Infant wide-field retinal image.
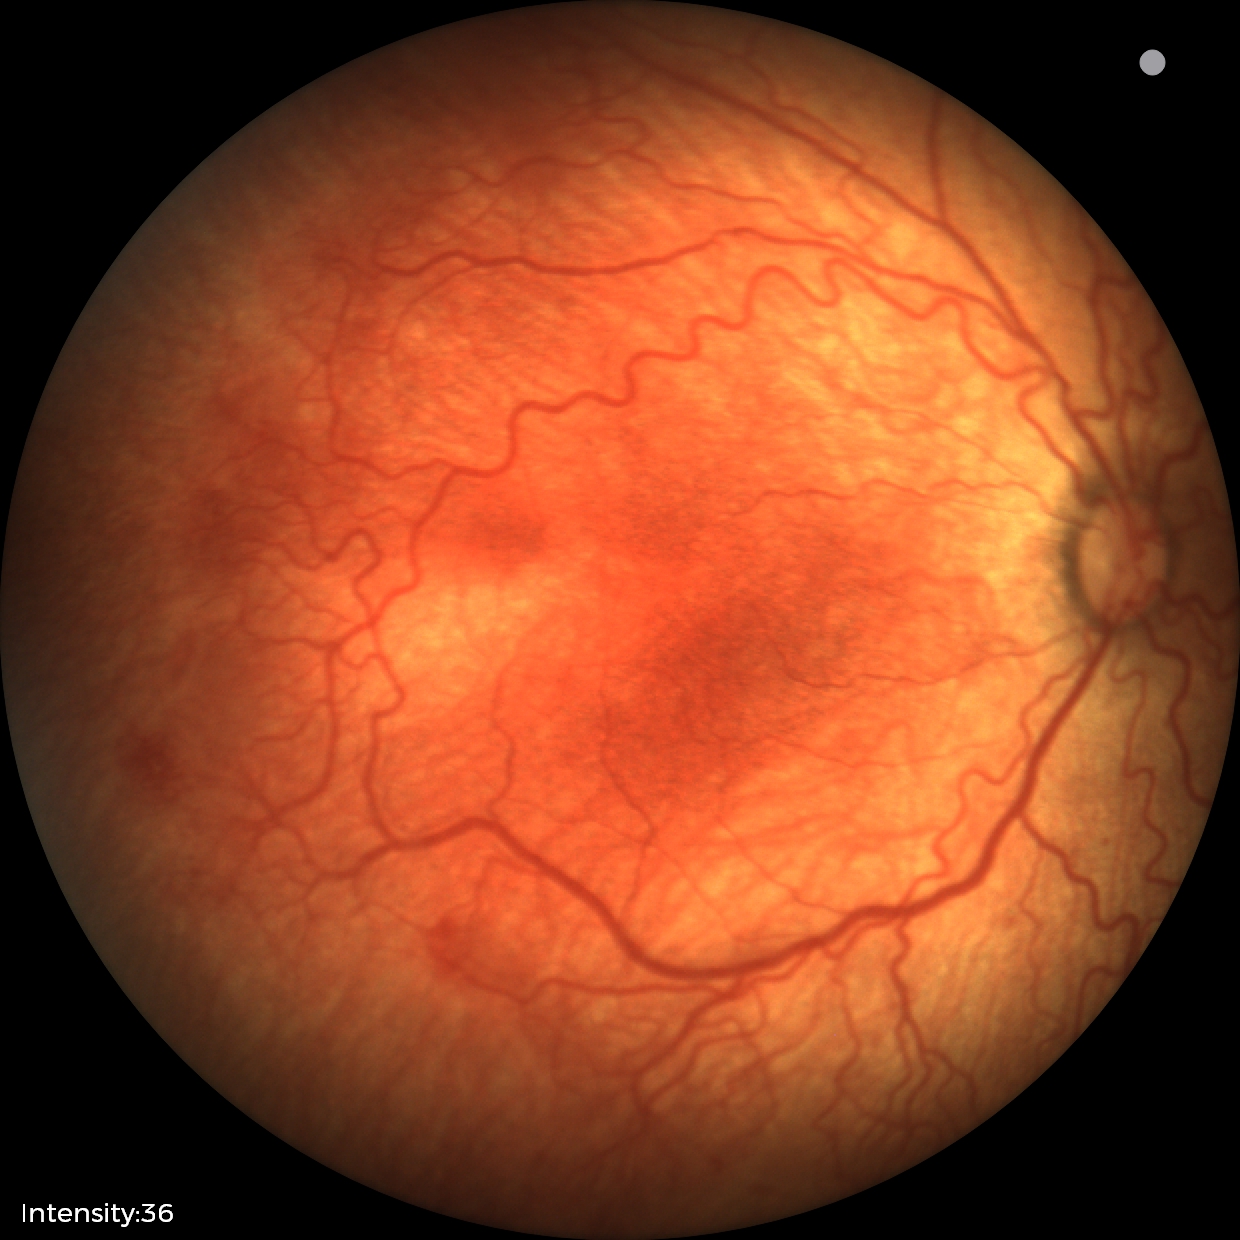
Assessment: plus disease | retinopathy of prematurity stage 2.